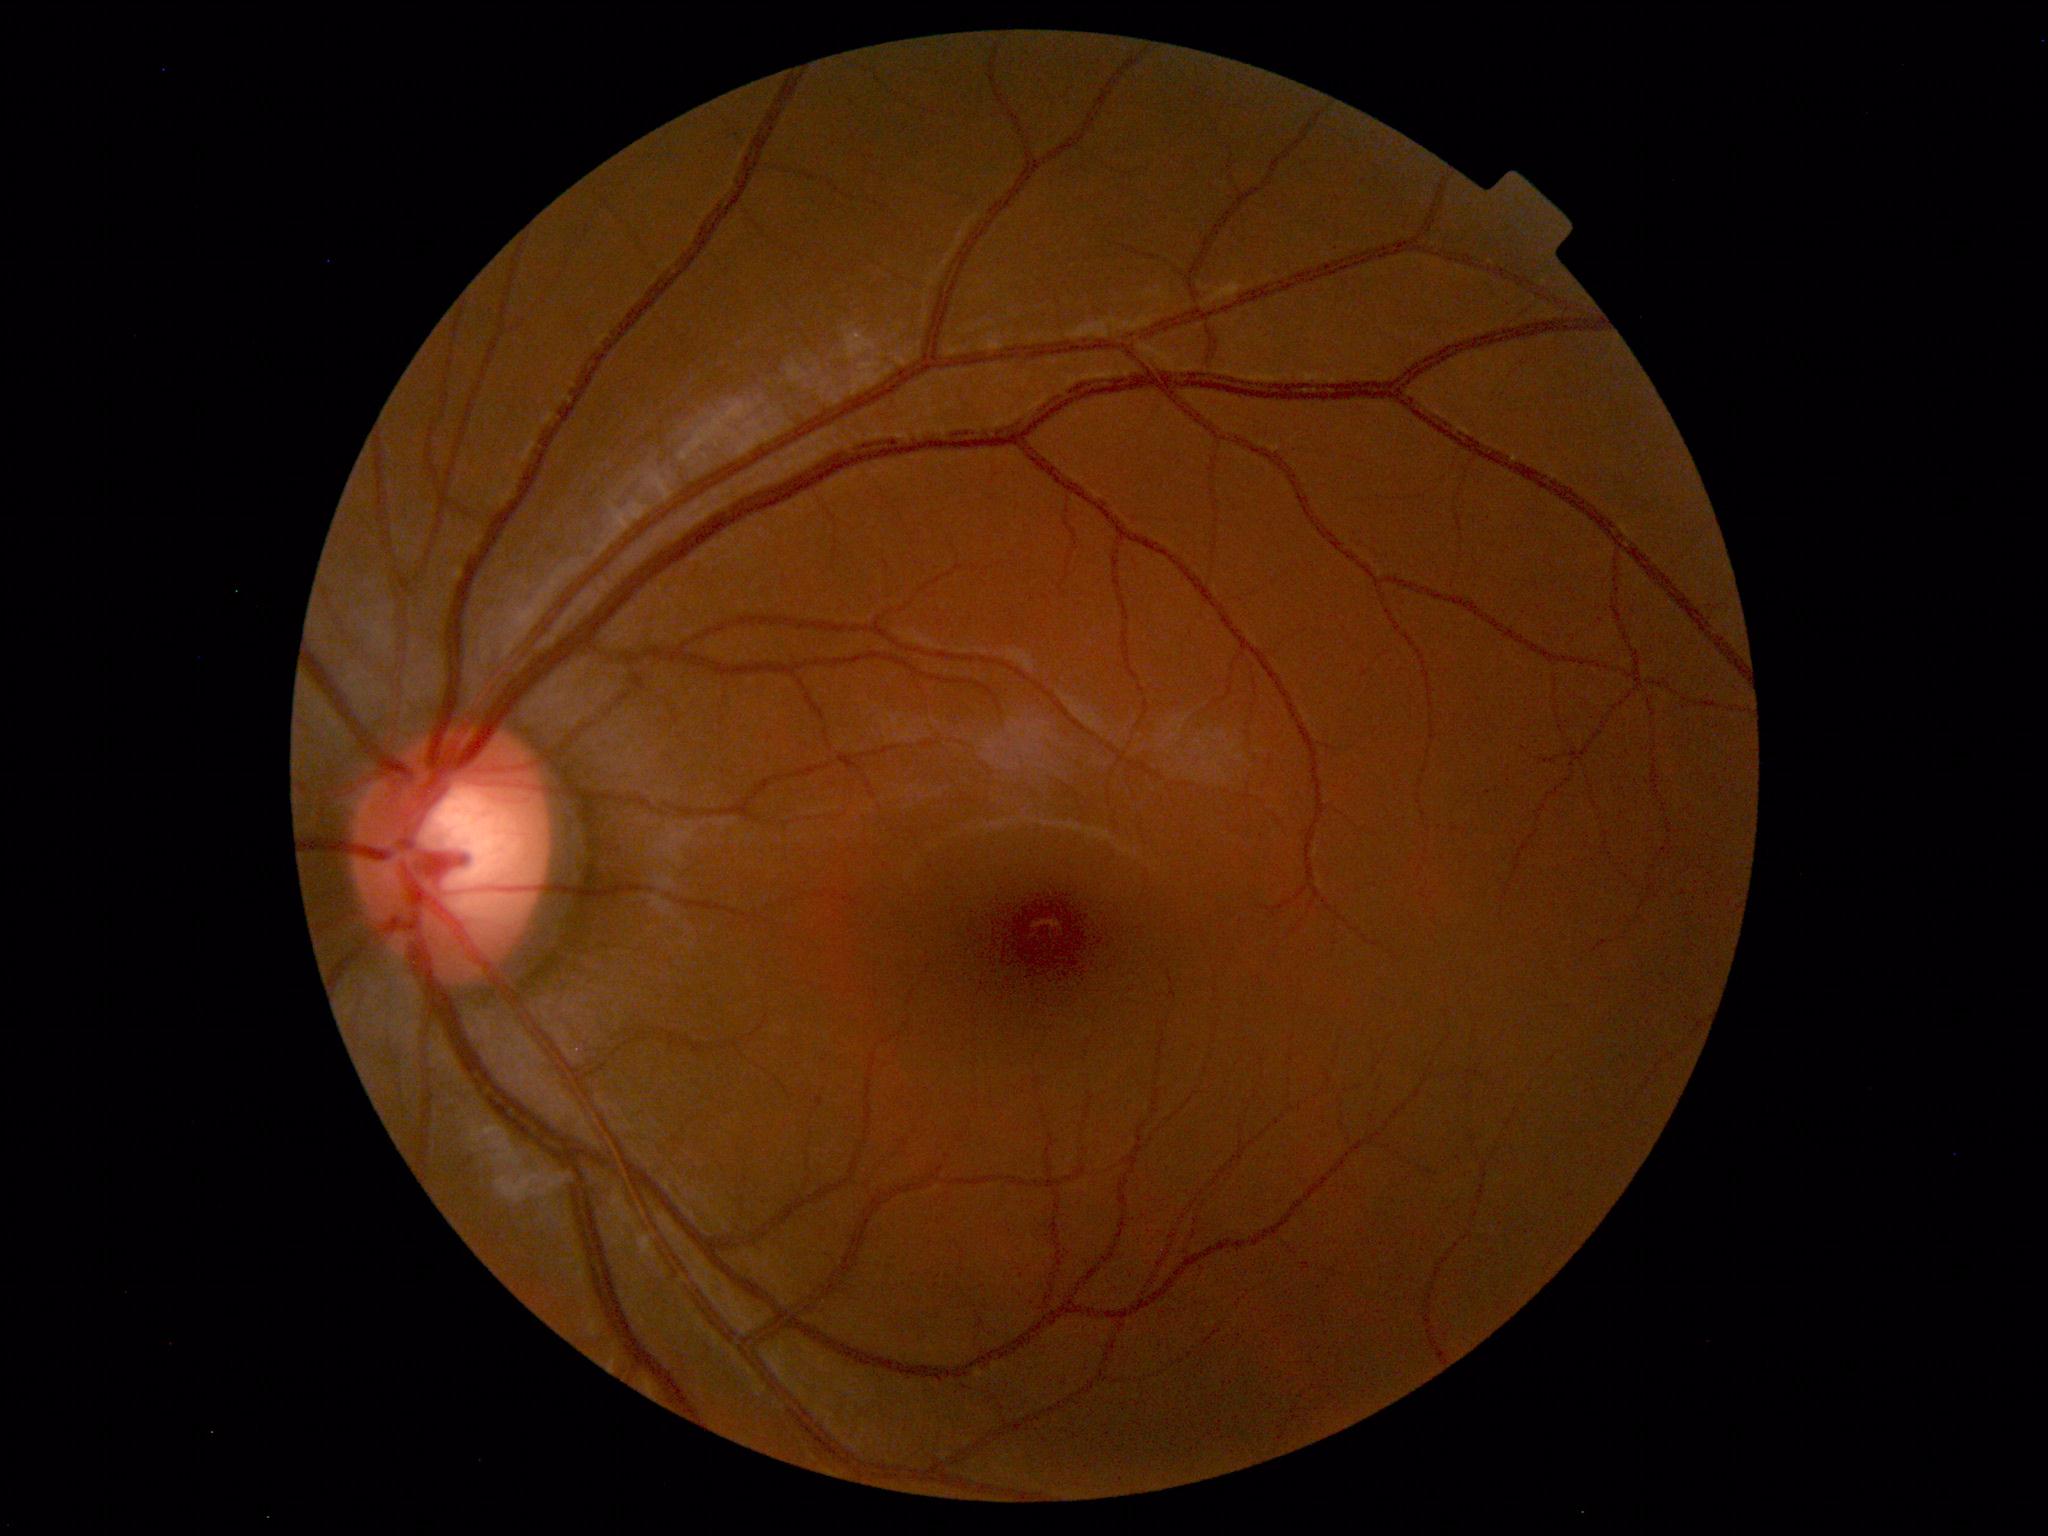 Fundus photograph within normal limits.